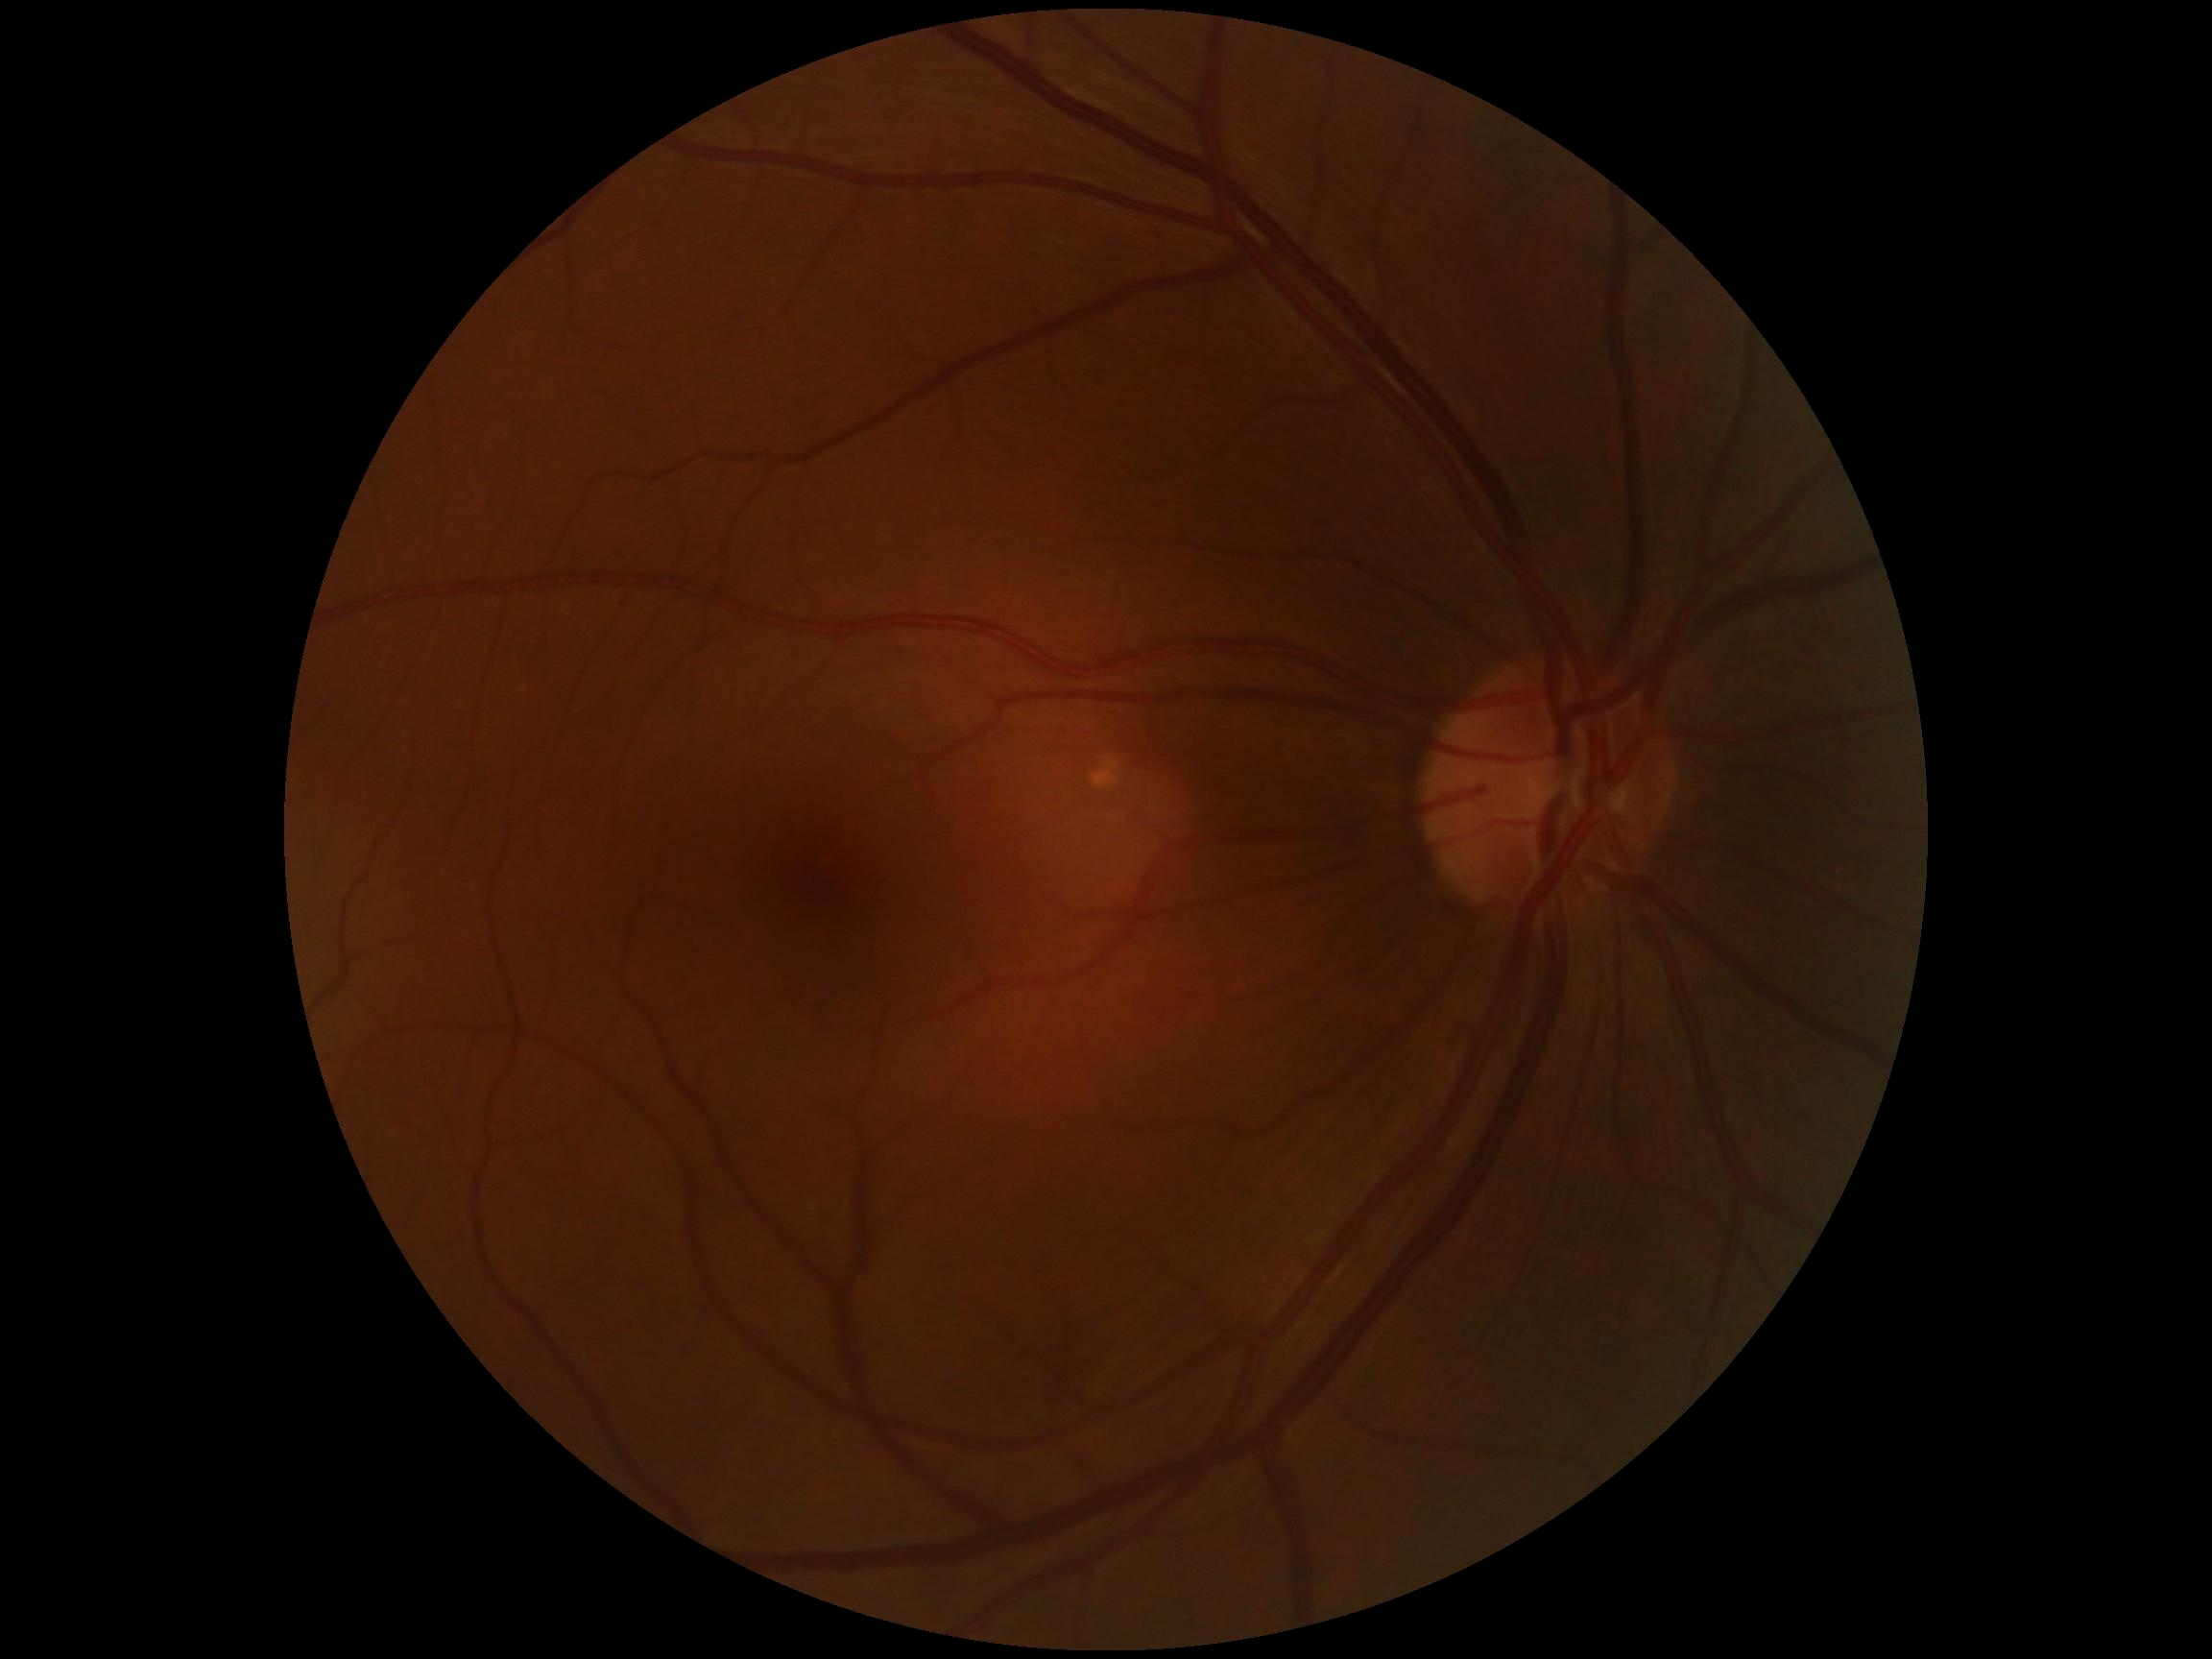 No apparent diabetic retinopathy.
DR stage is no apparent retinopathy (grade 0).